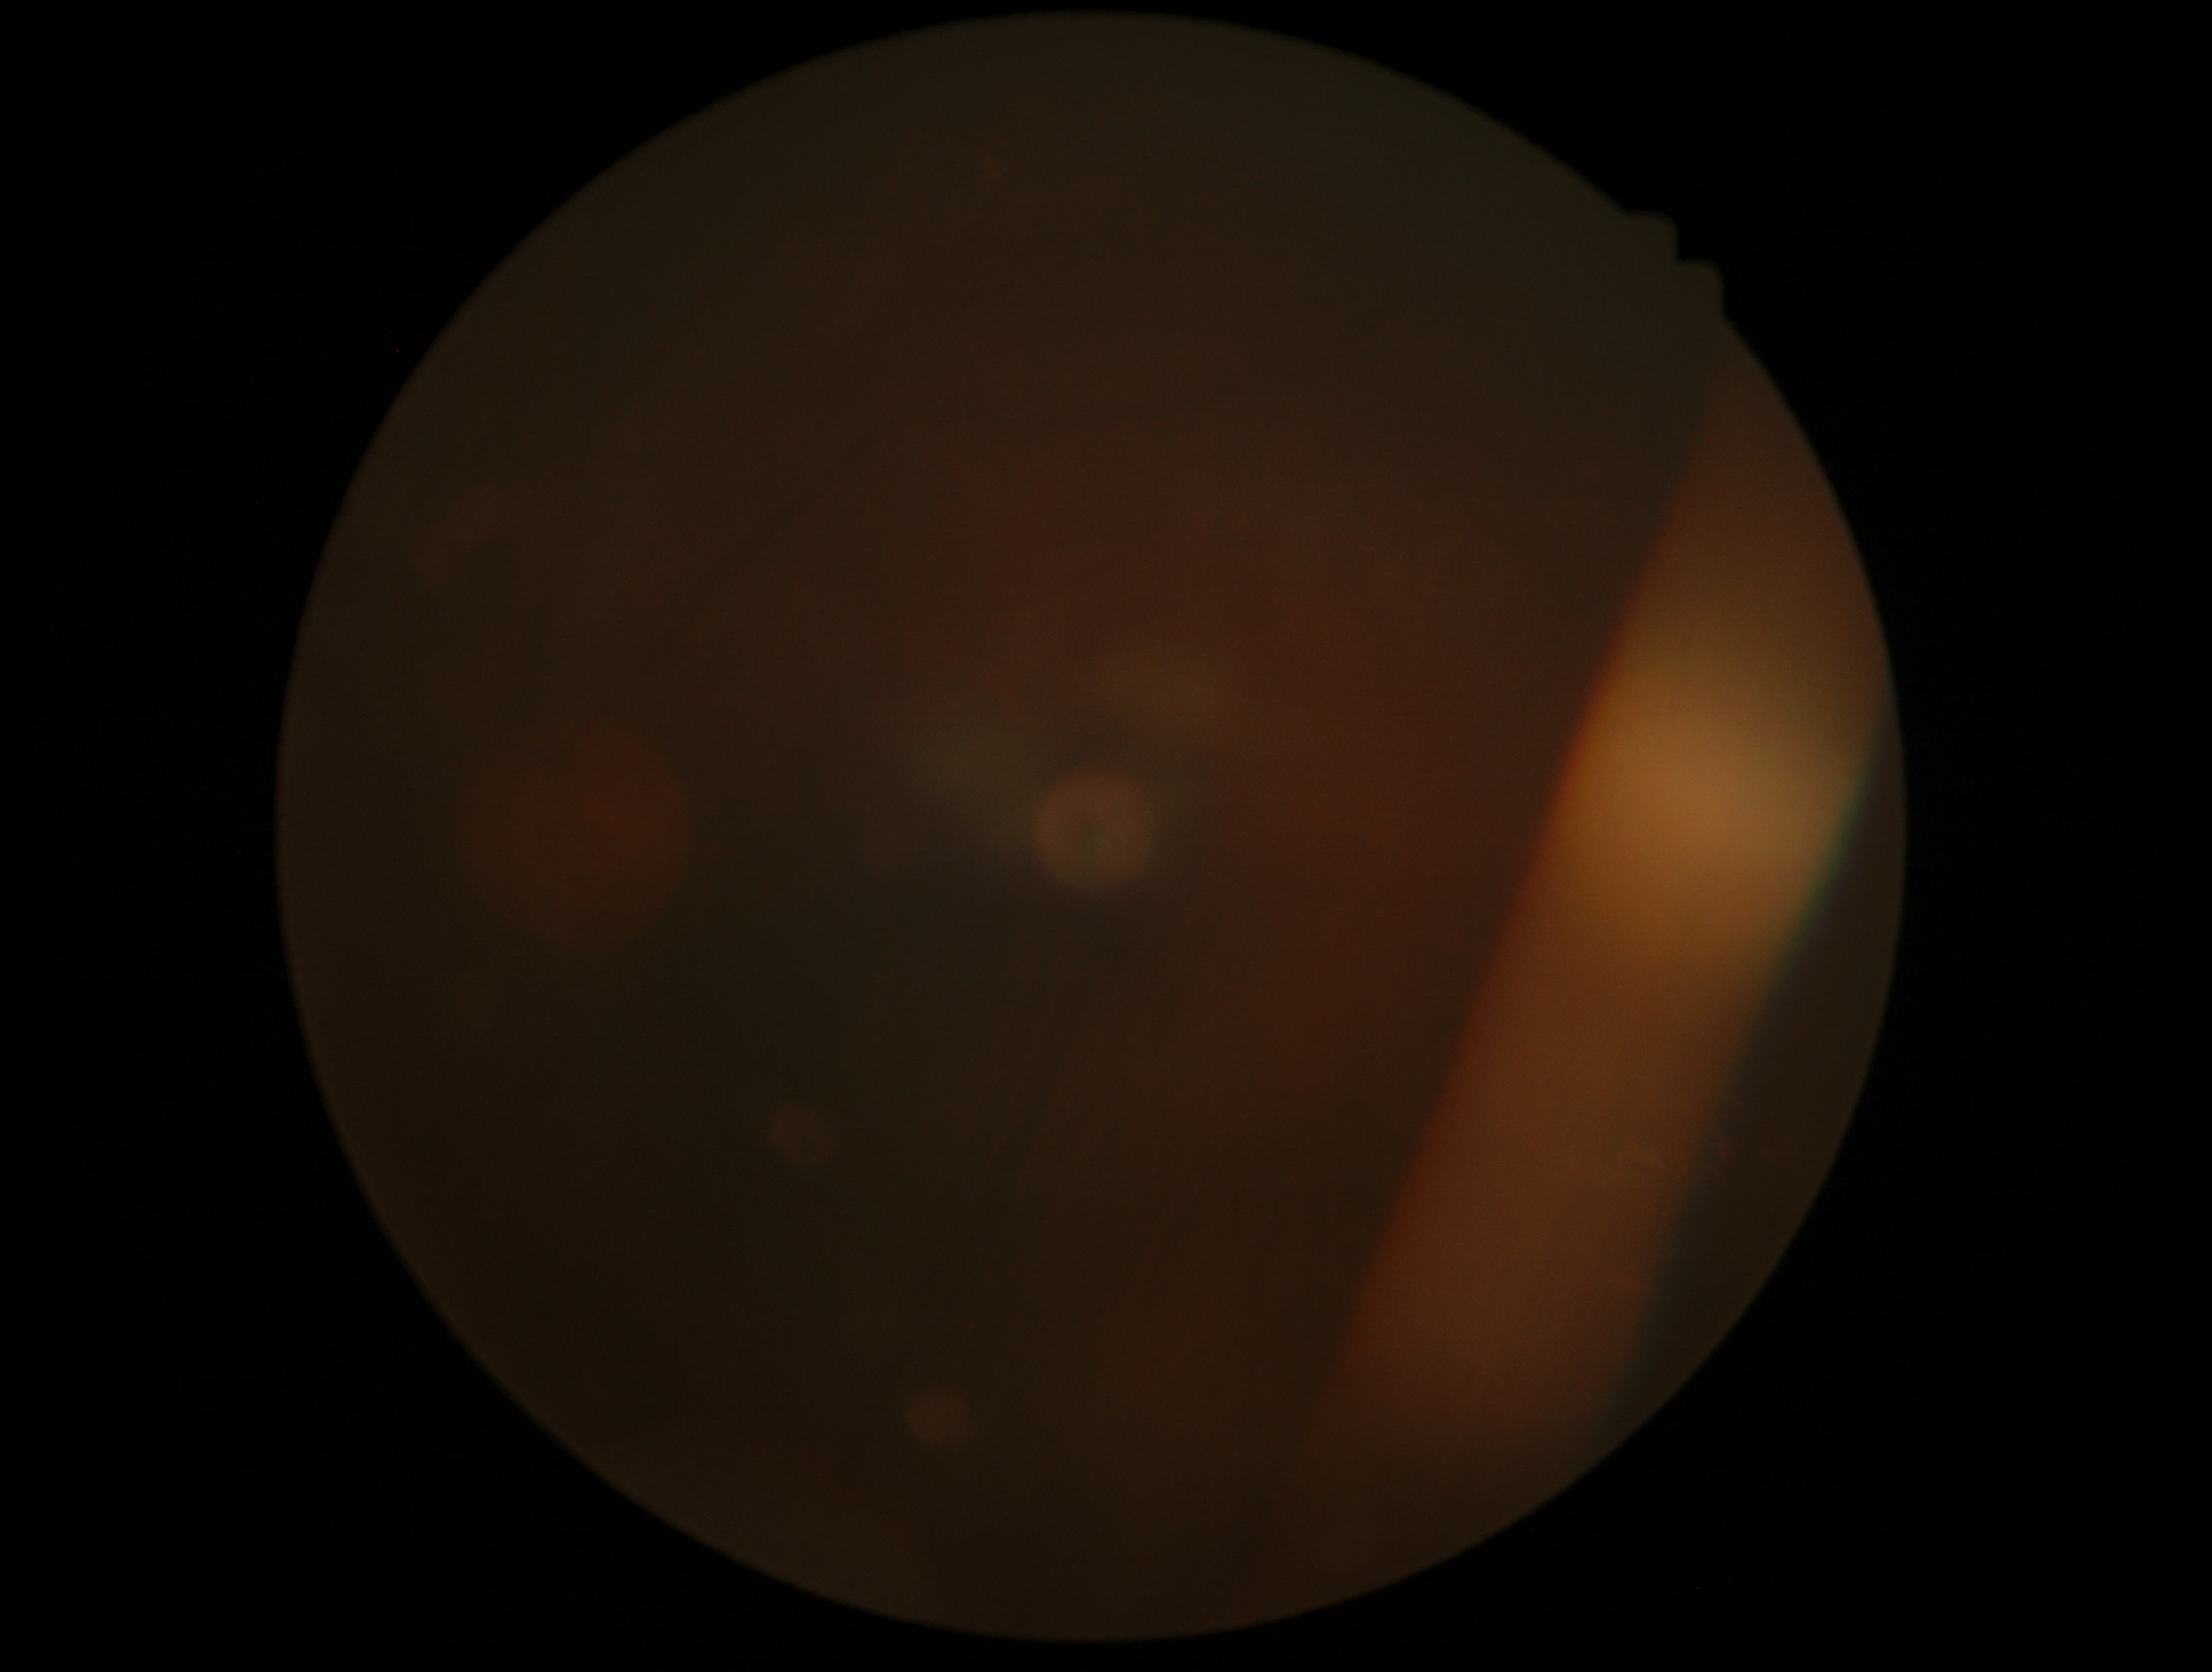
Diabetic retinopathy grade: ungradable due to poor image quality.
Image quality is insufficient for diabetic retinopathy assessment.